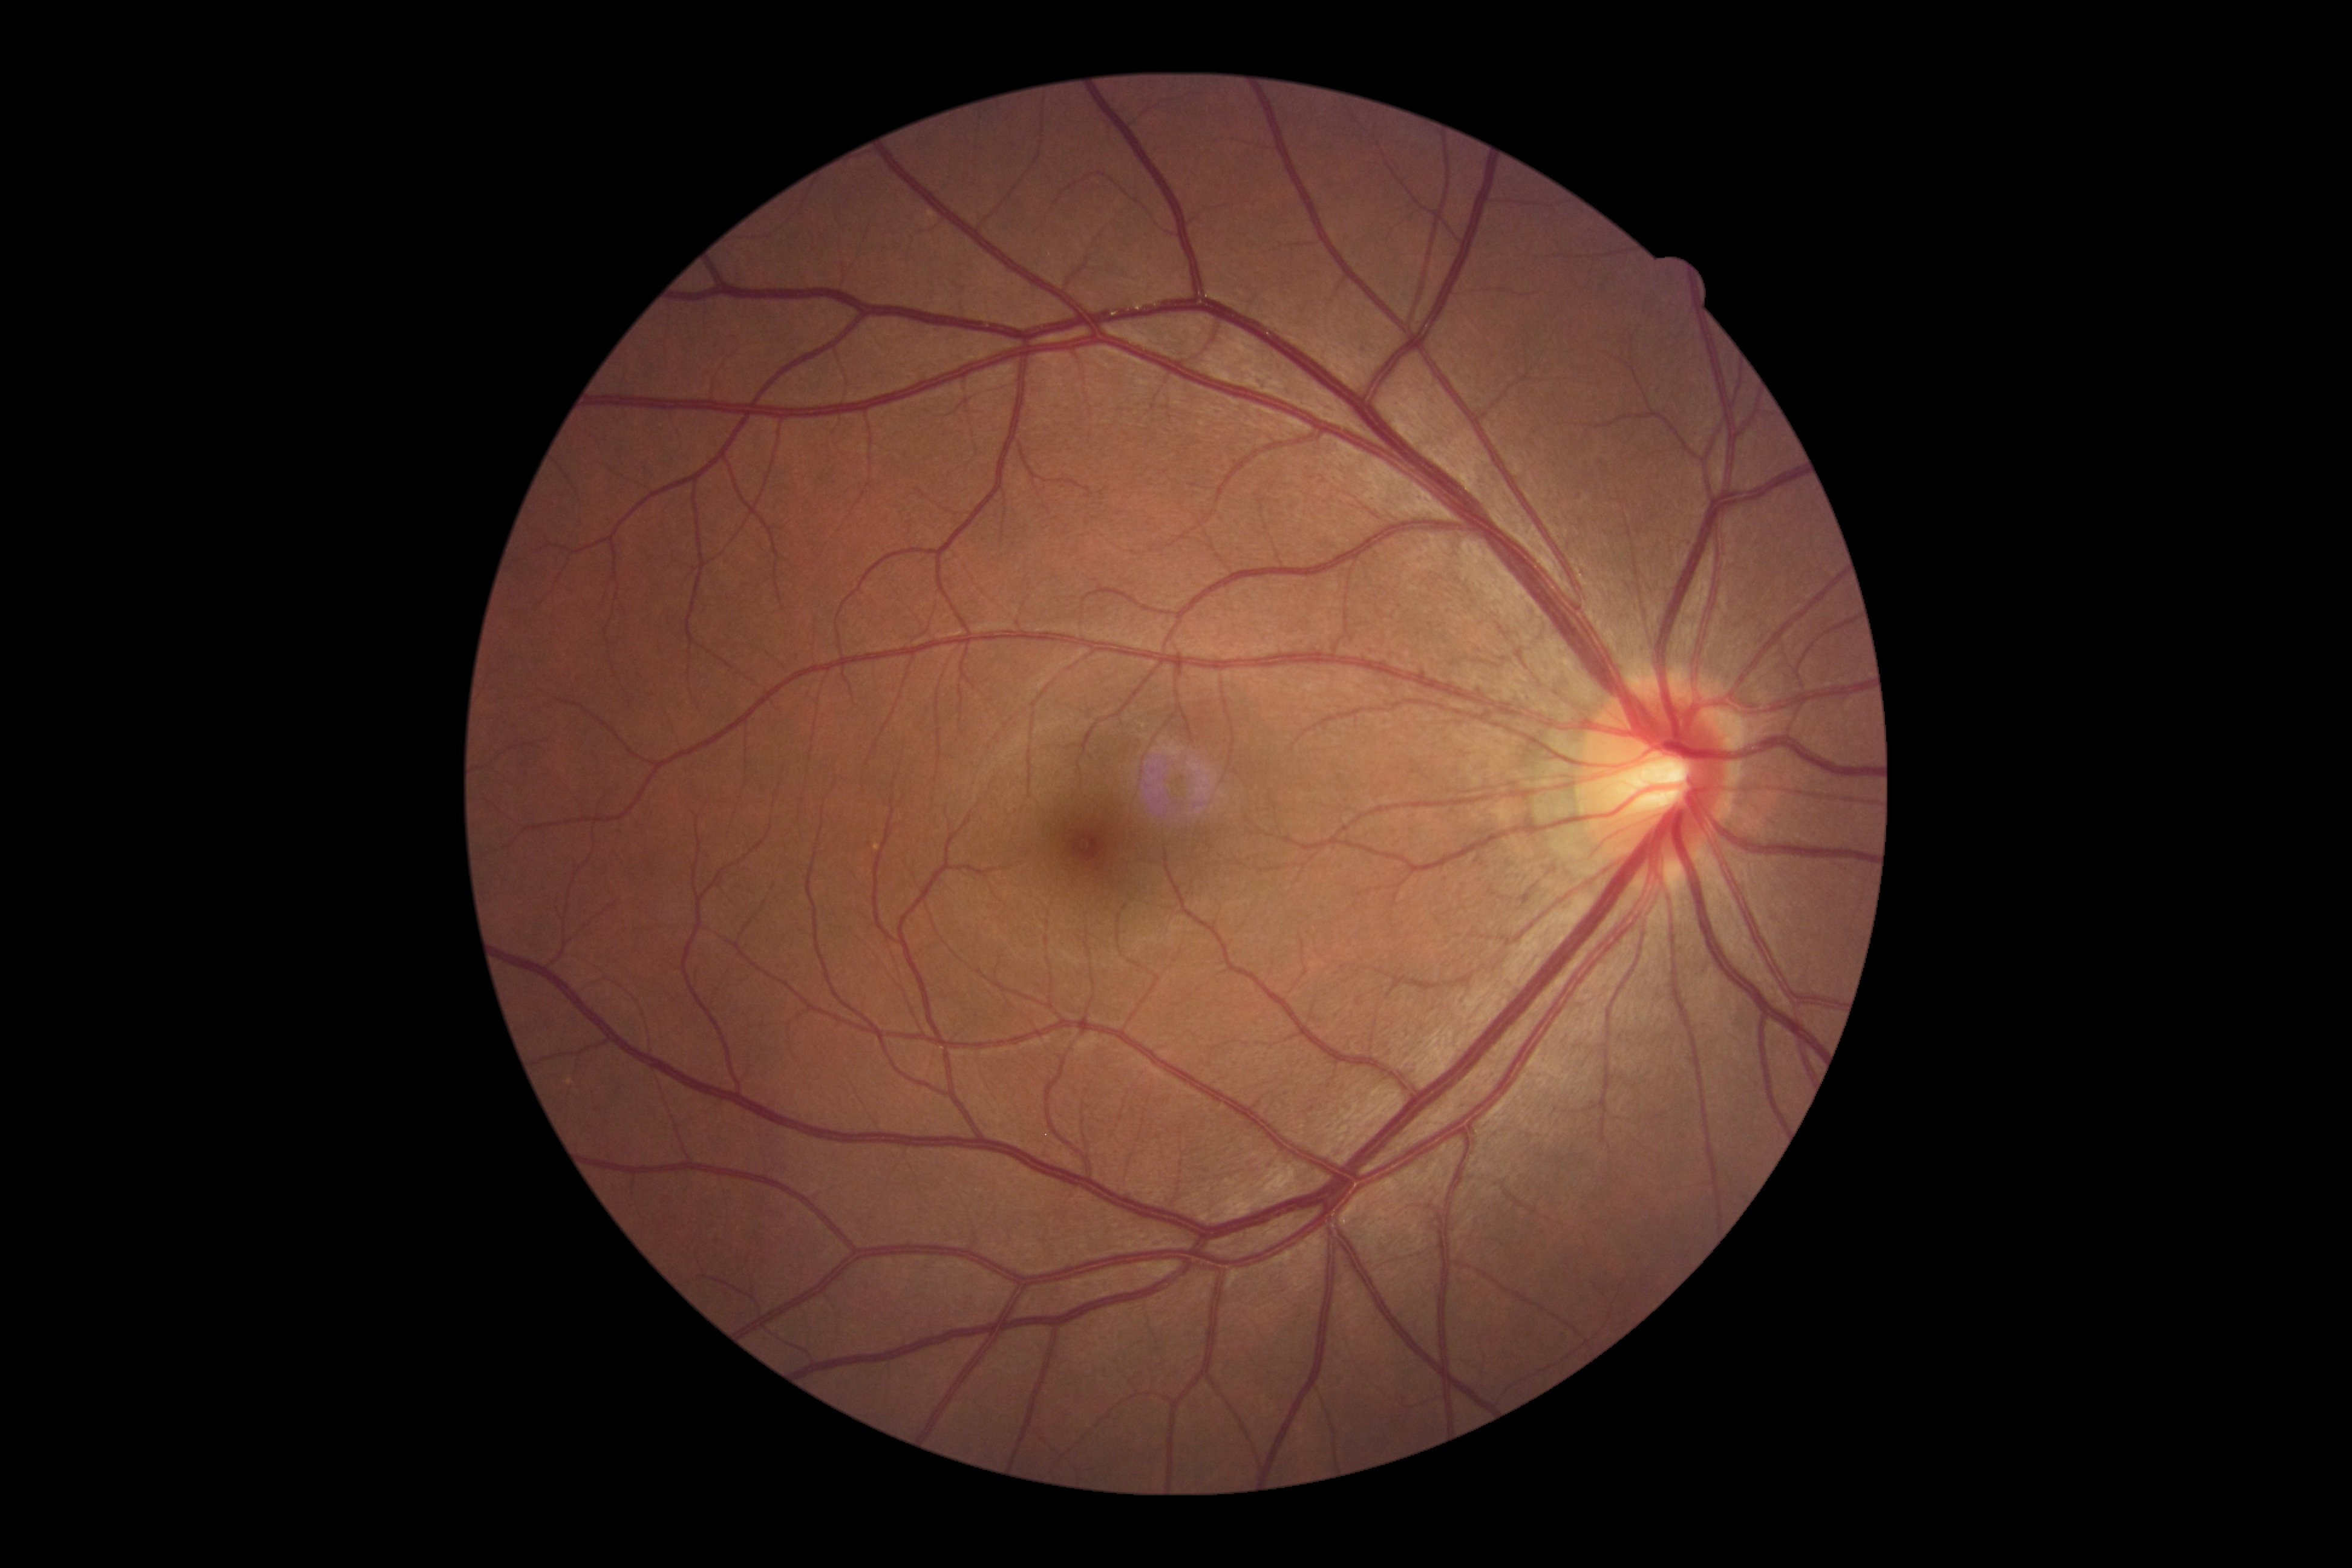

DR: grade 0 (no apparent retinopathy). No signs of diabetic retinopathy.